45° field of view; acquired with a NIDEK AFC-230; without pupil dilation; graded on the modified Davis scale.
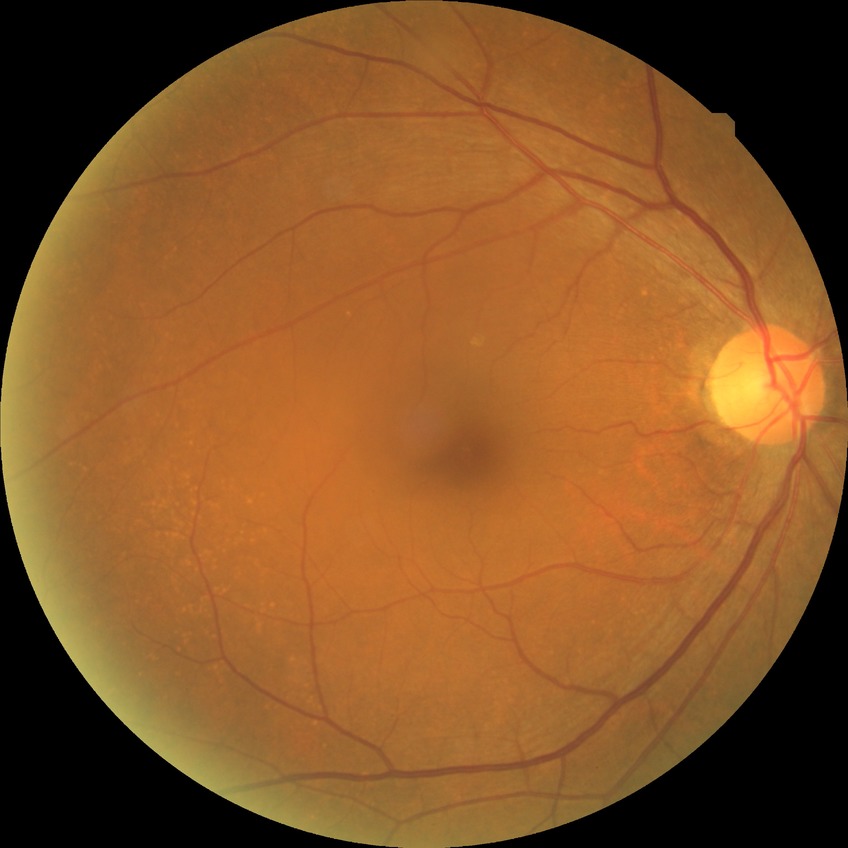

diabetic retinopathy (DR)=no diabetic retinopathy (NDR).